2048x1536 · 45-degree field of view
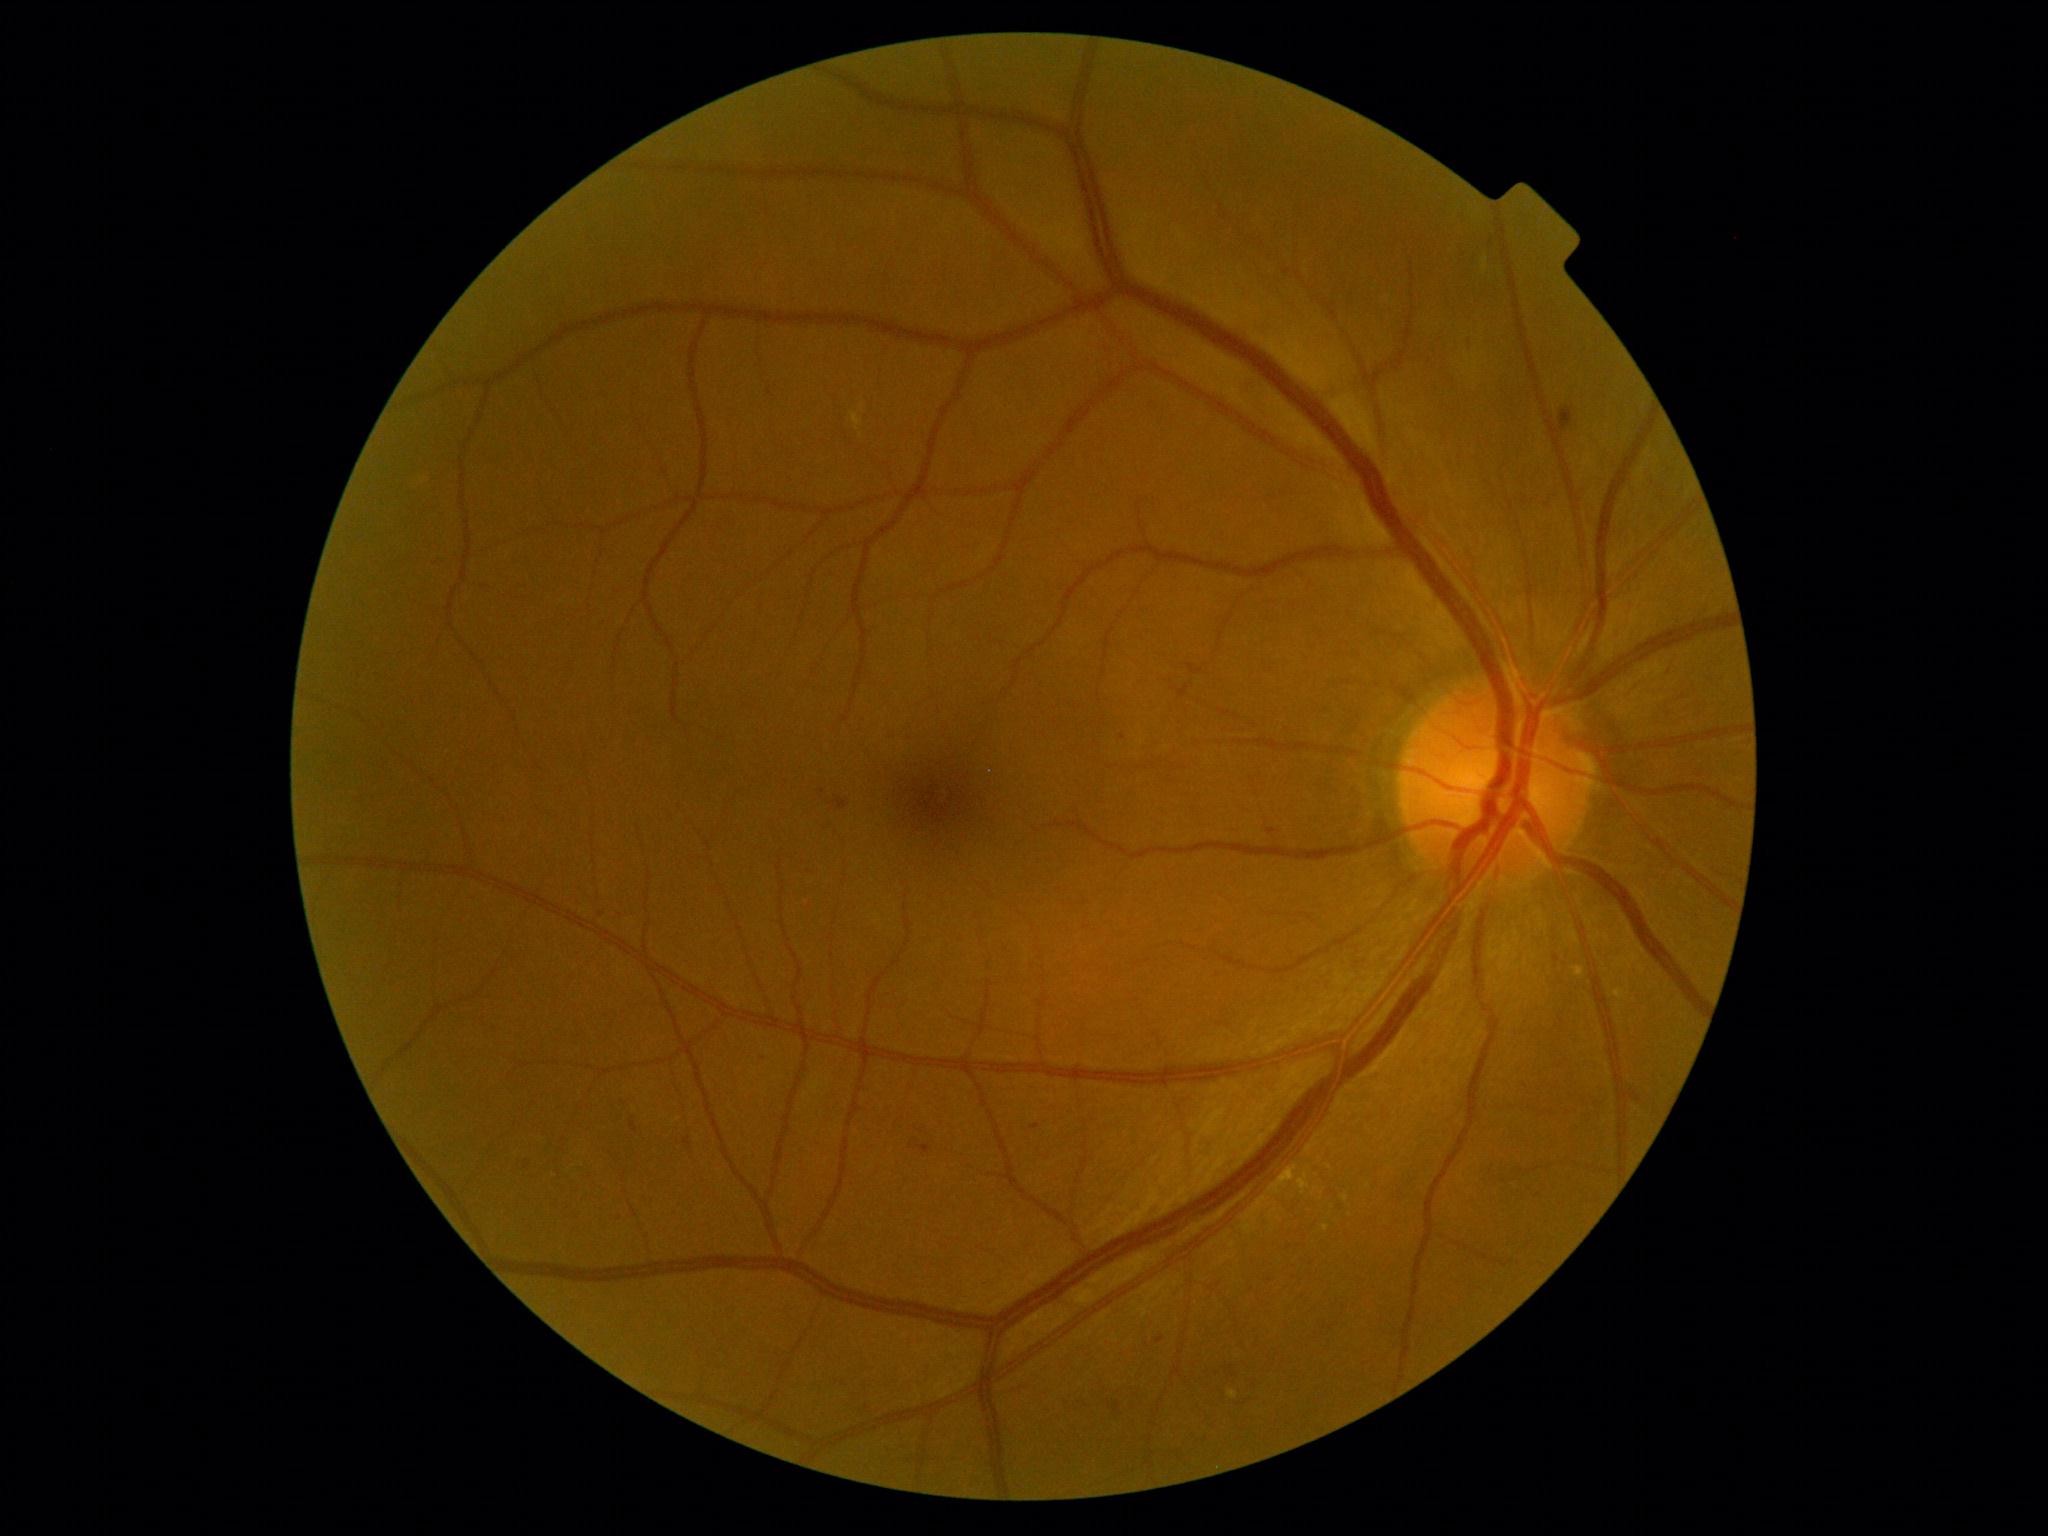
DR severity is 2/4.